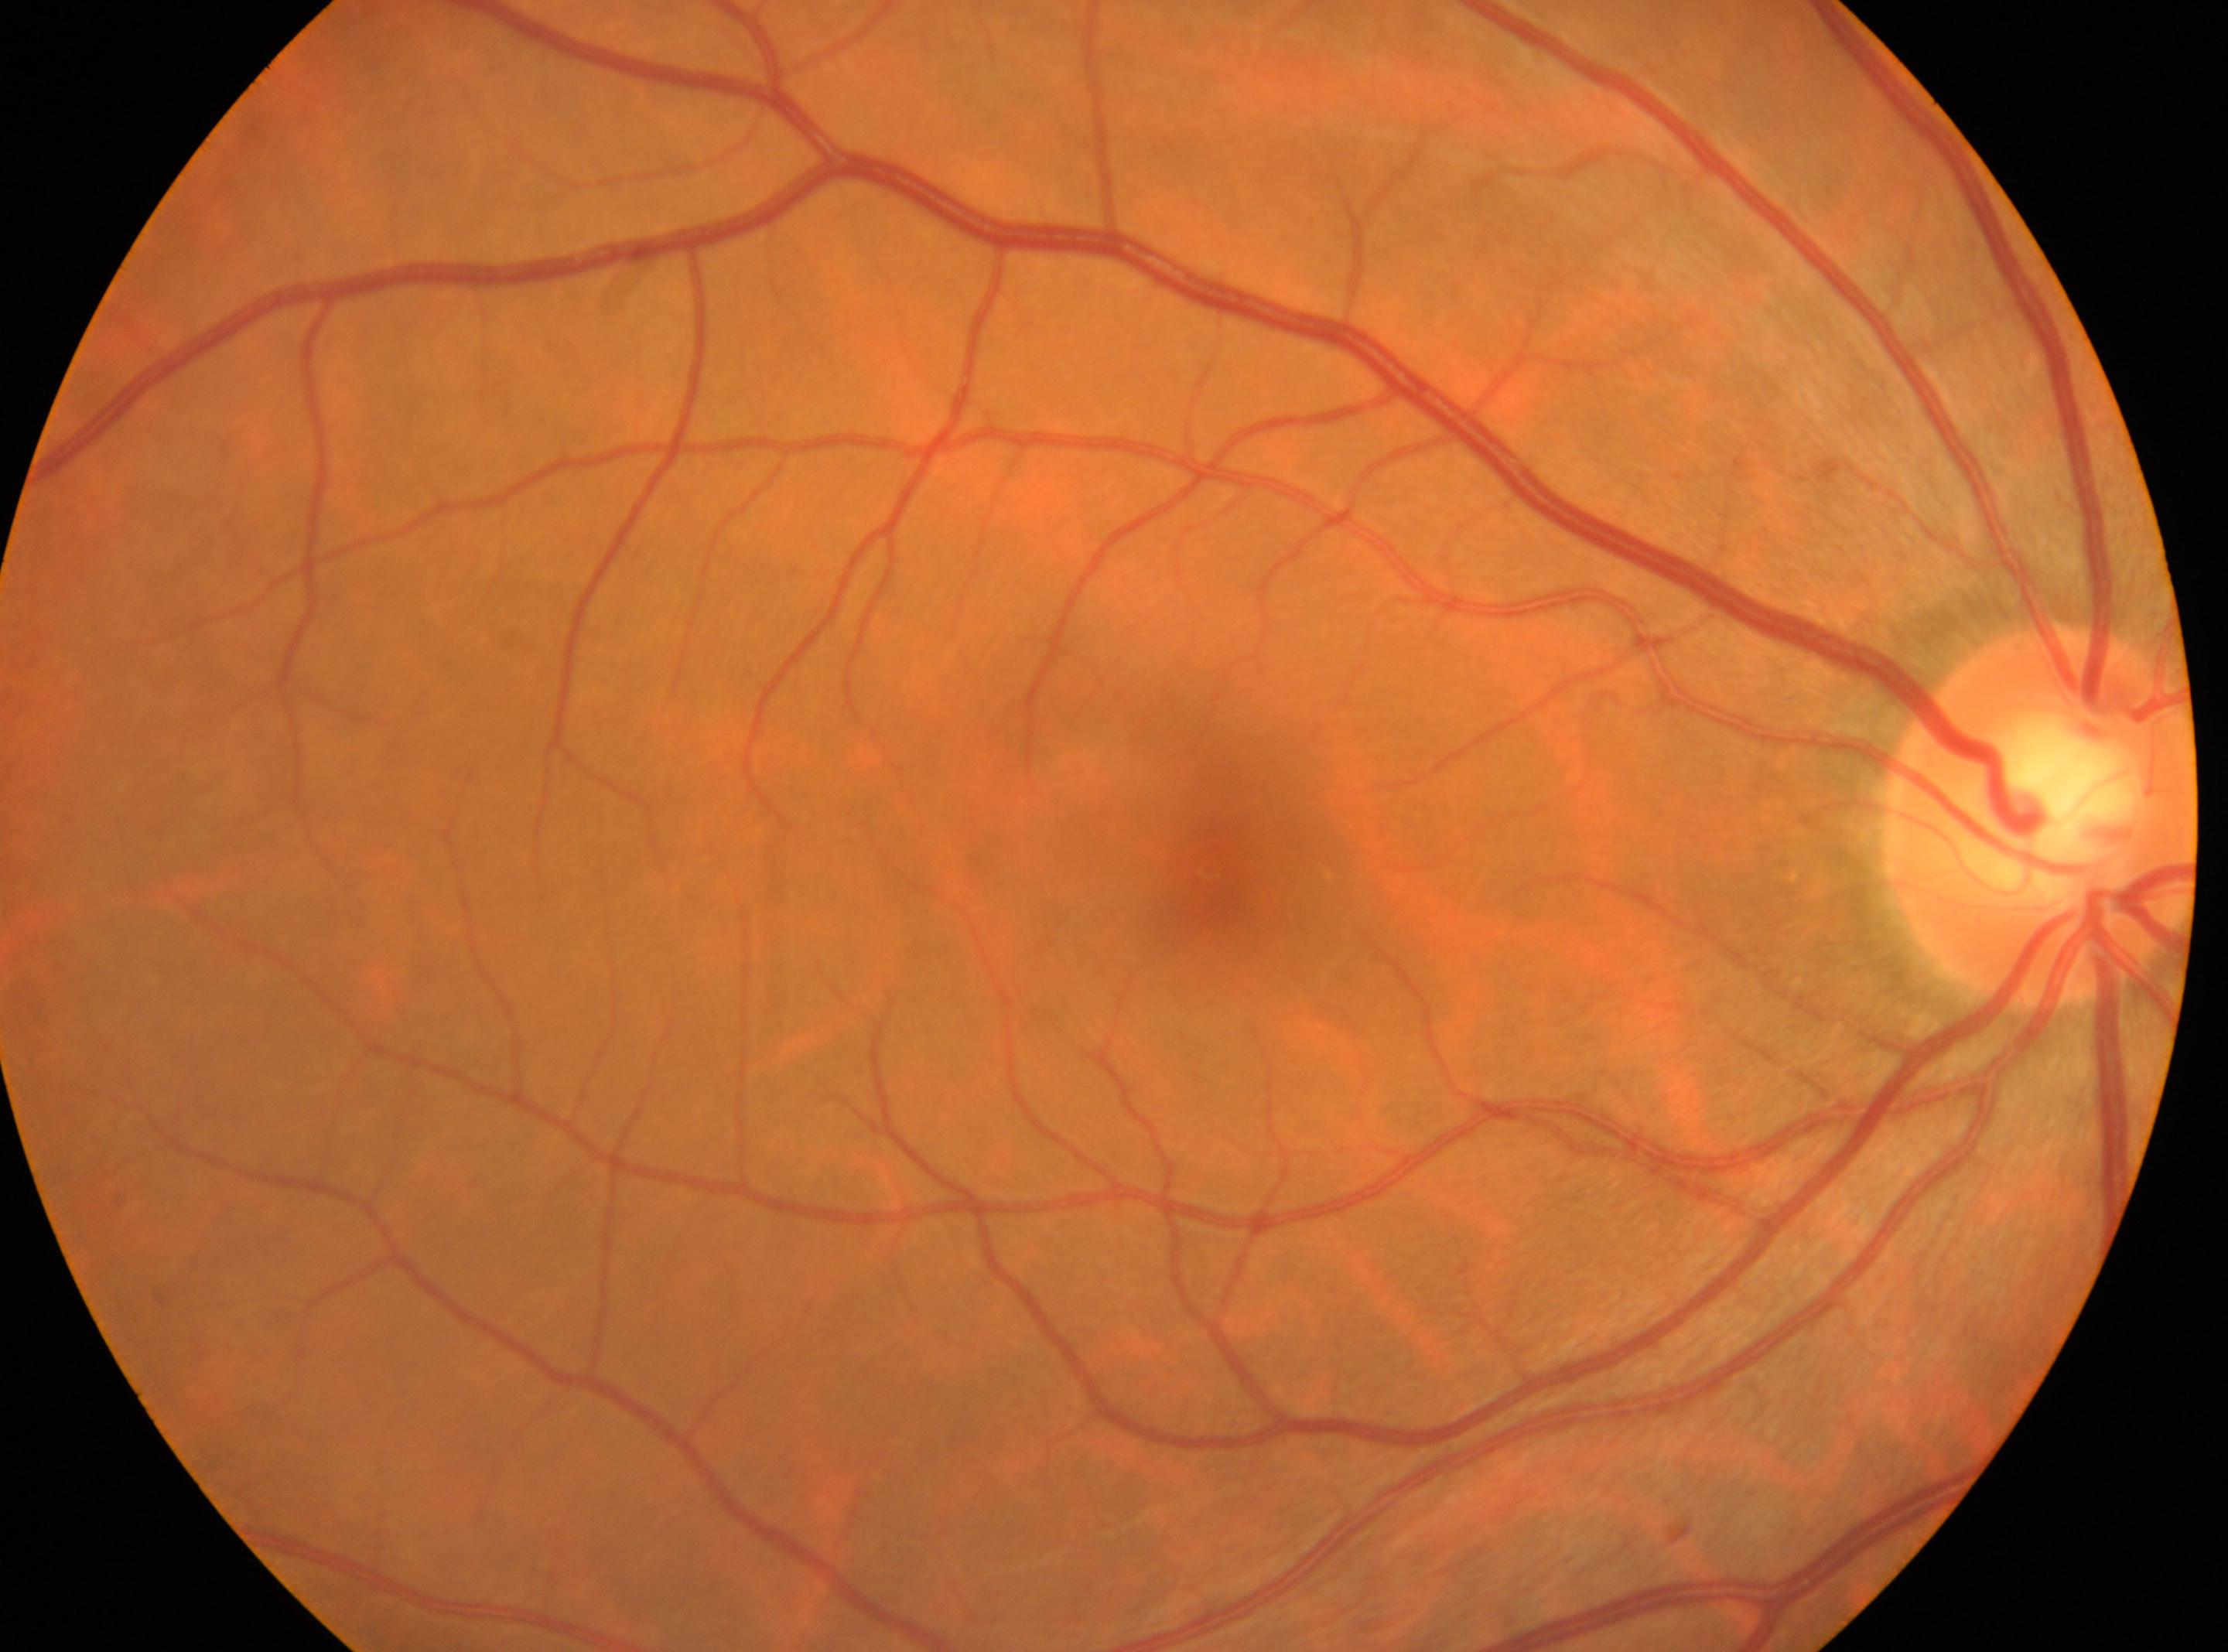
Q: What is the laterality?
A: oculus dexter
Q: Locate the optic disc.
A: (2041,814)
Q: Fovea center?
A: (1207,871)
Q: What is the DR grade?
A: grade 0 (no apparent retinopathy)